Graded on the modified Davis scale:
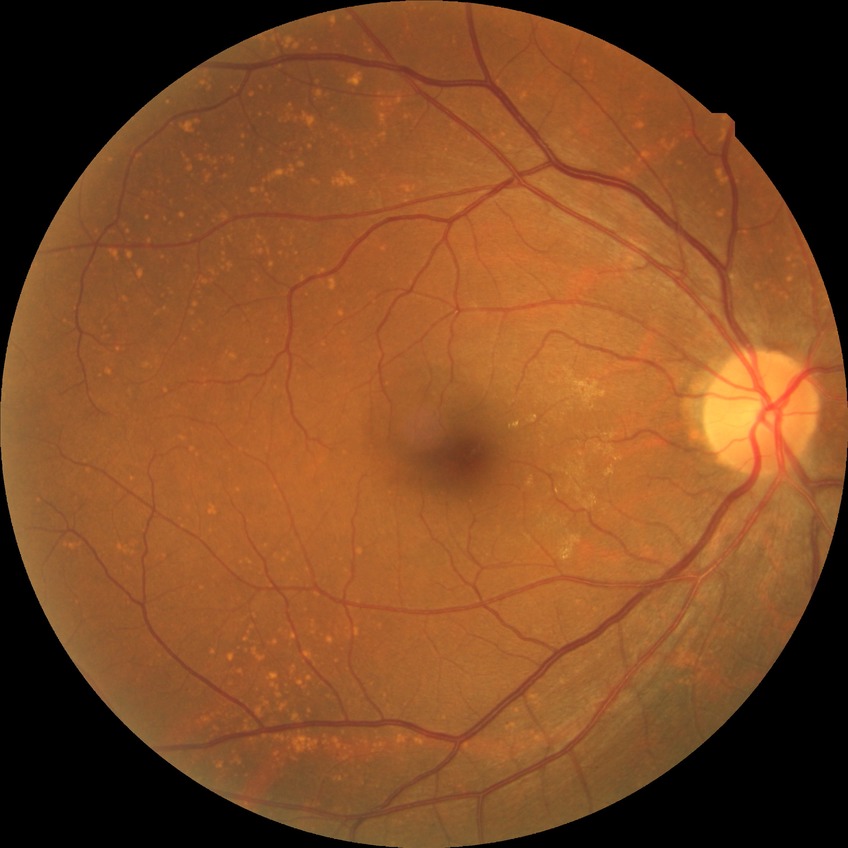

No diabetic retinal disease findings. DR: NDR.